2048x1536px: 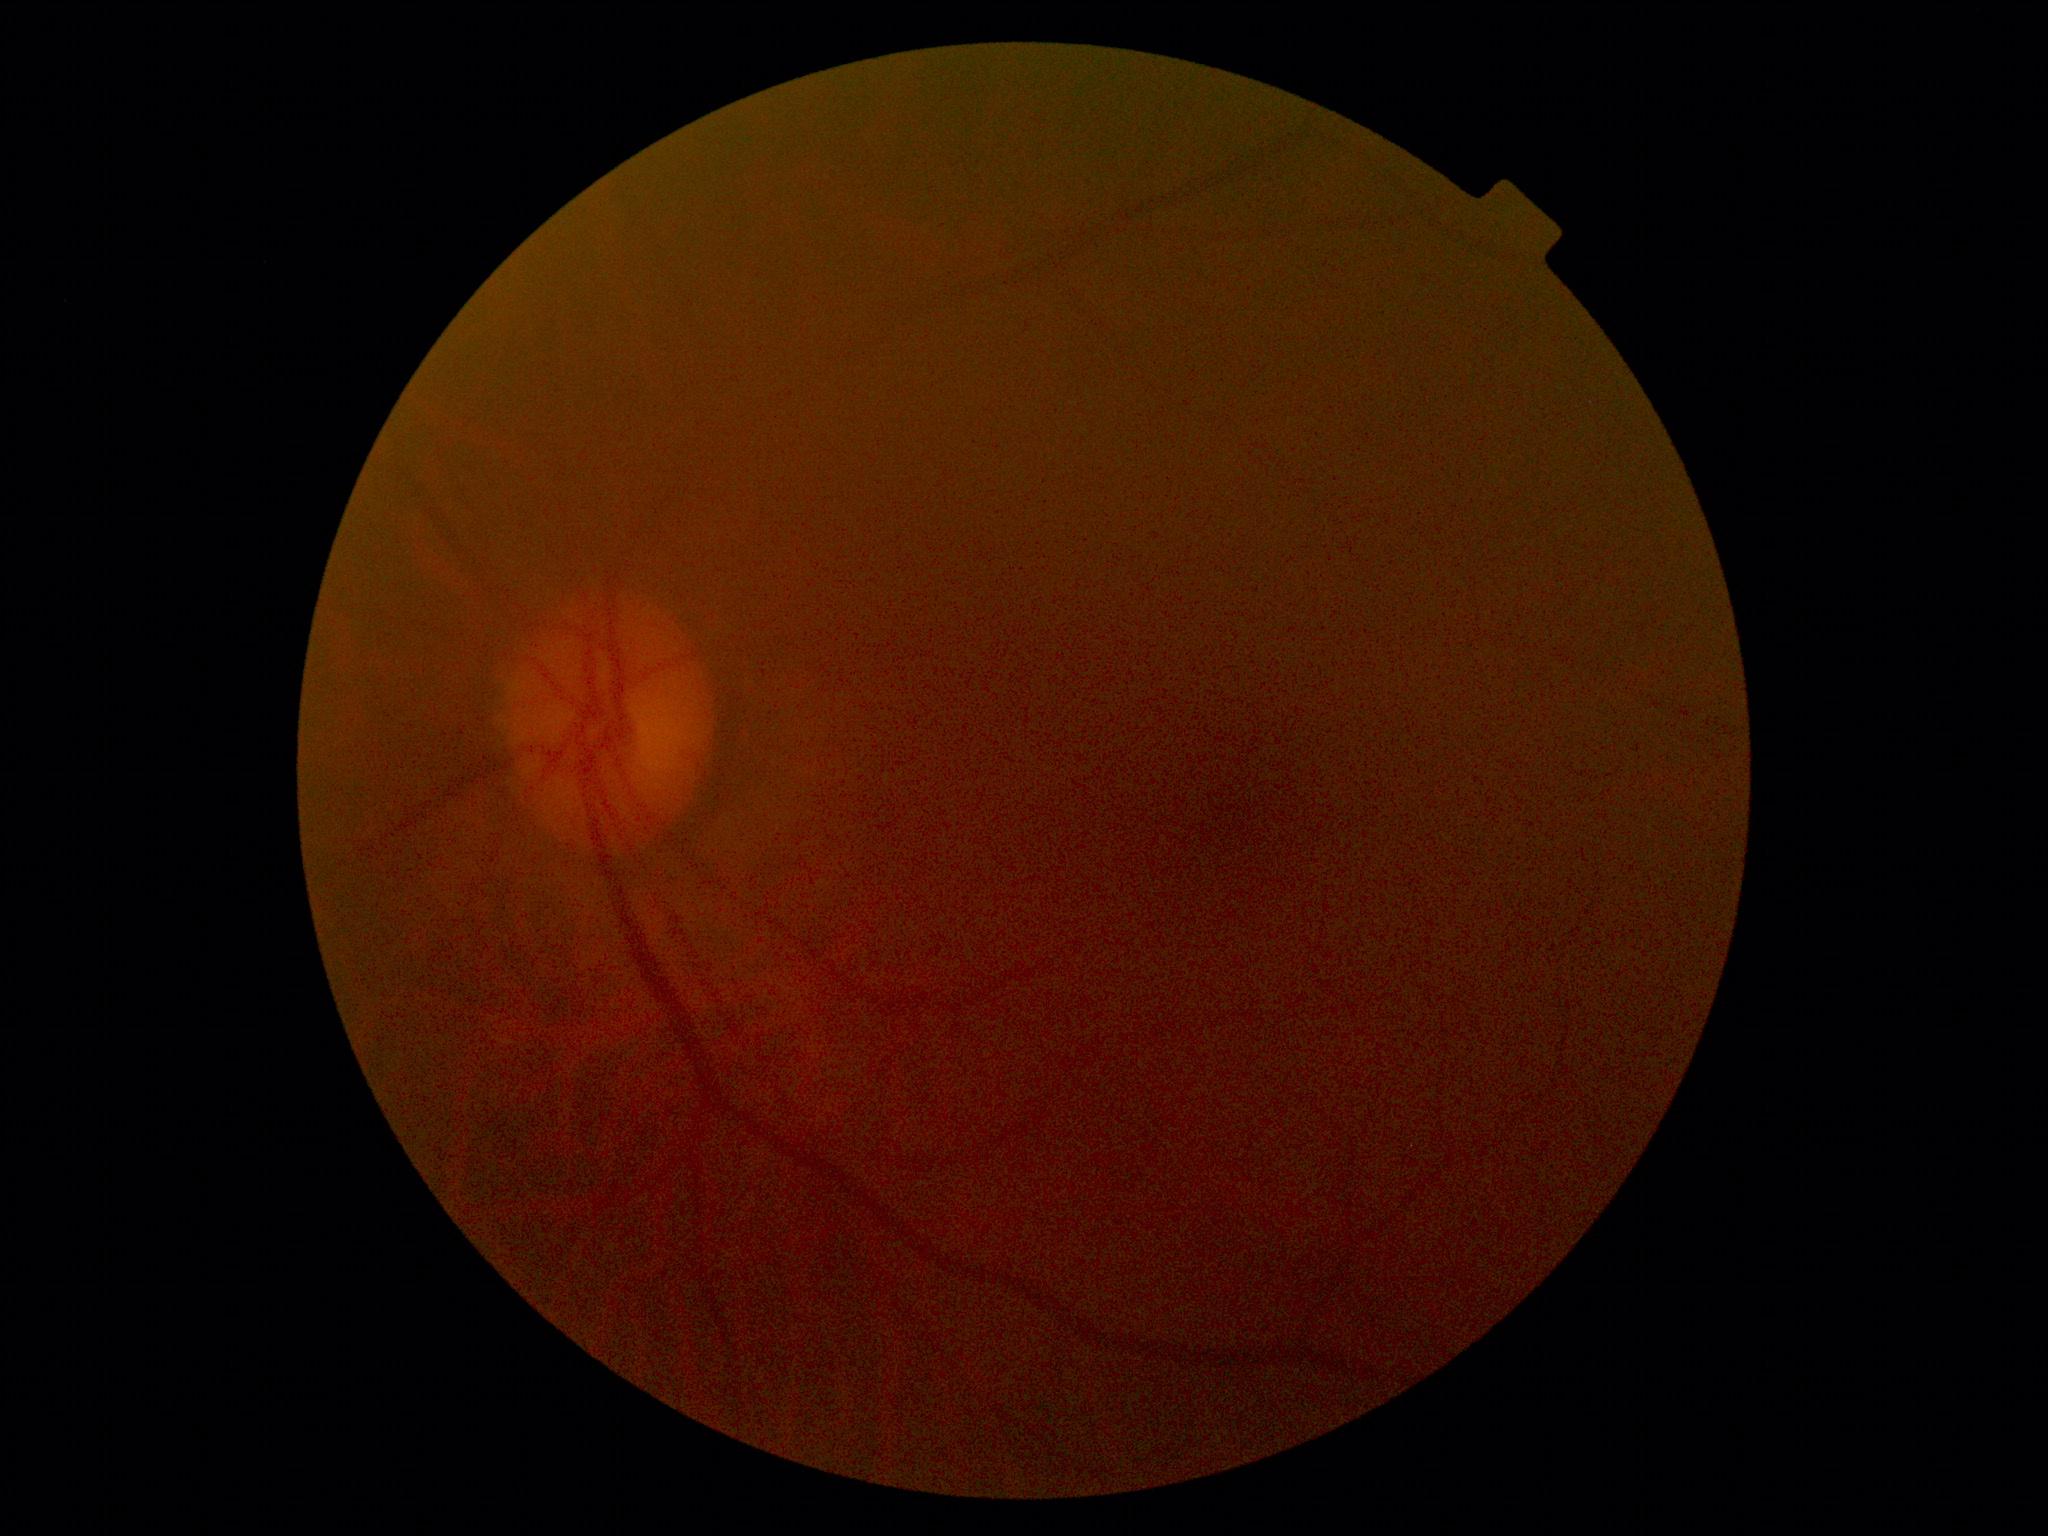

DR severity: ungradable due to poor image quality. Ungradable image — DR severity cannot be determined.